130° field of view (Natus RetCam Envision). Infant wide-field fundus photograph. 1440 x 1080 pixels:
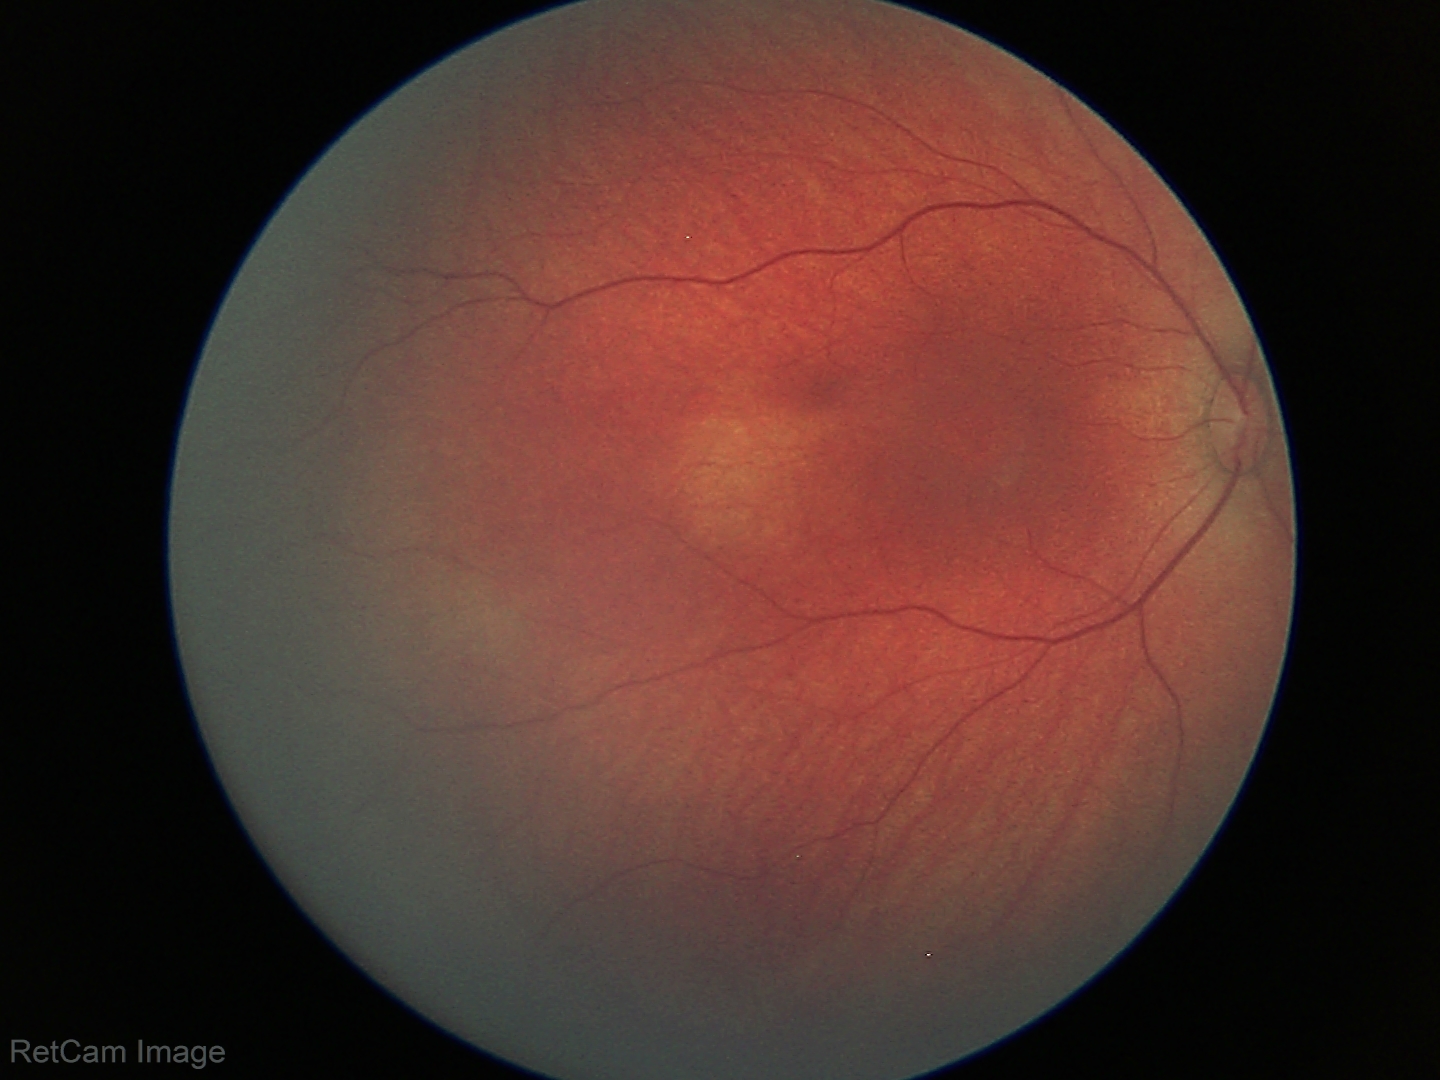

Assessment: physiological appearance with no retinal pathology.